1440x1080px. Infant wide-field fundus photograph:
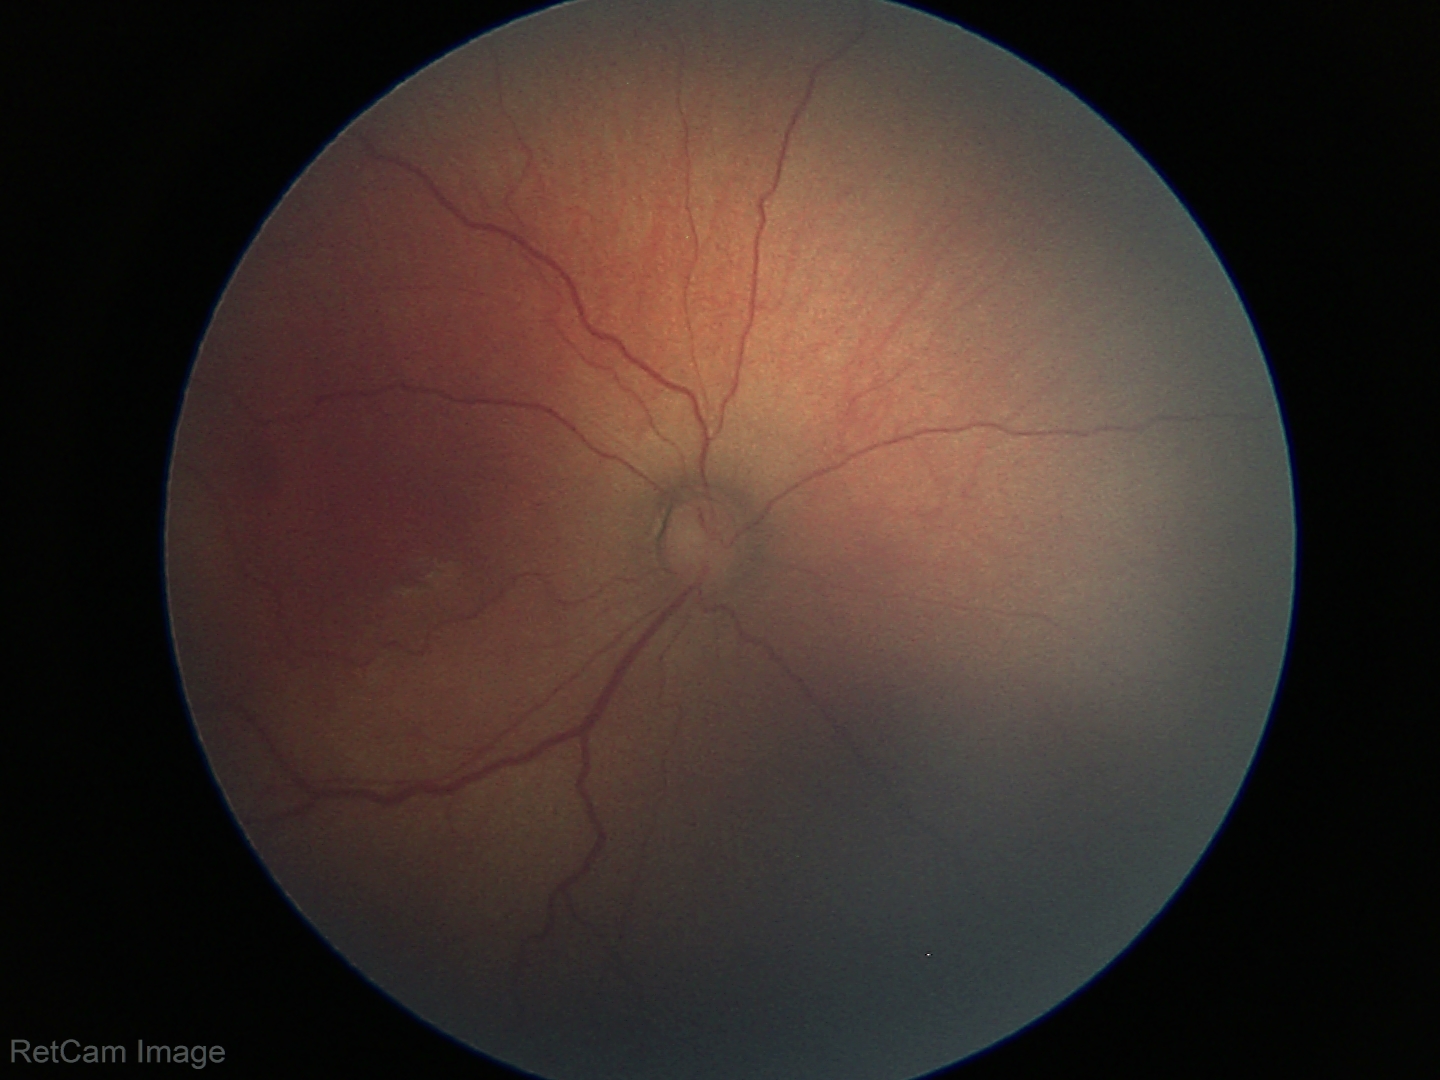

Screening series with ROP stage 2 — ridge with height and width at the demarcation line.